45-degree field of view · retinal fundus photograph · 2048x1536px: 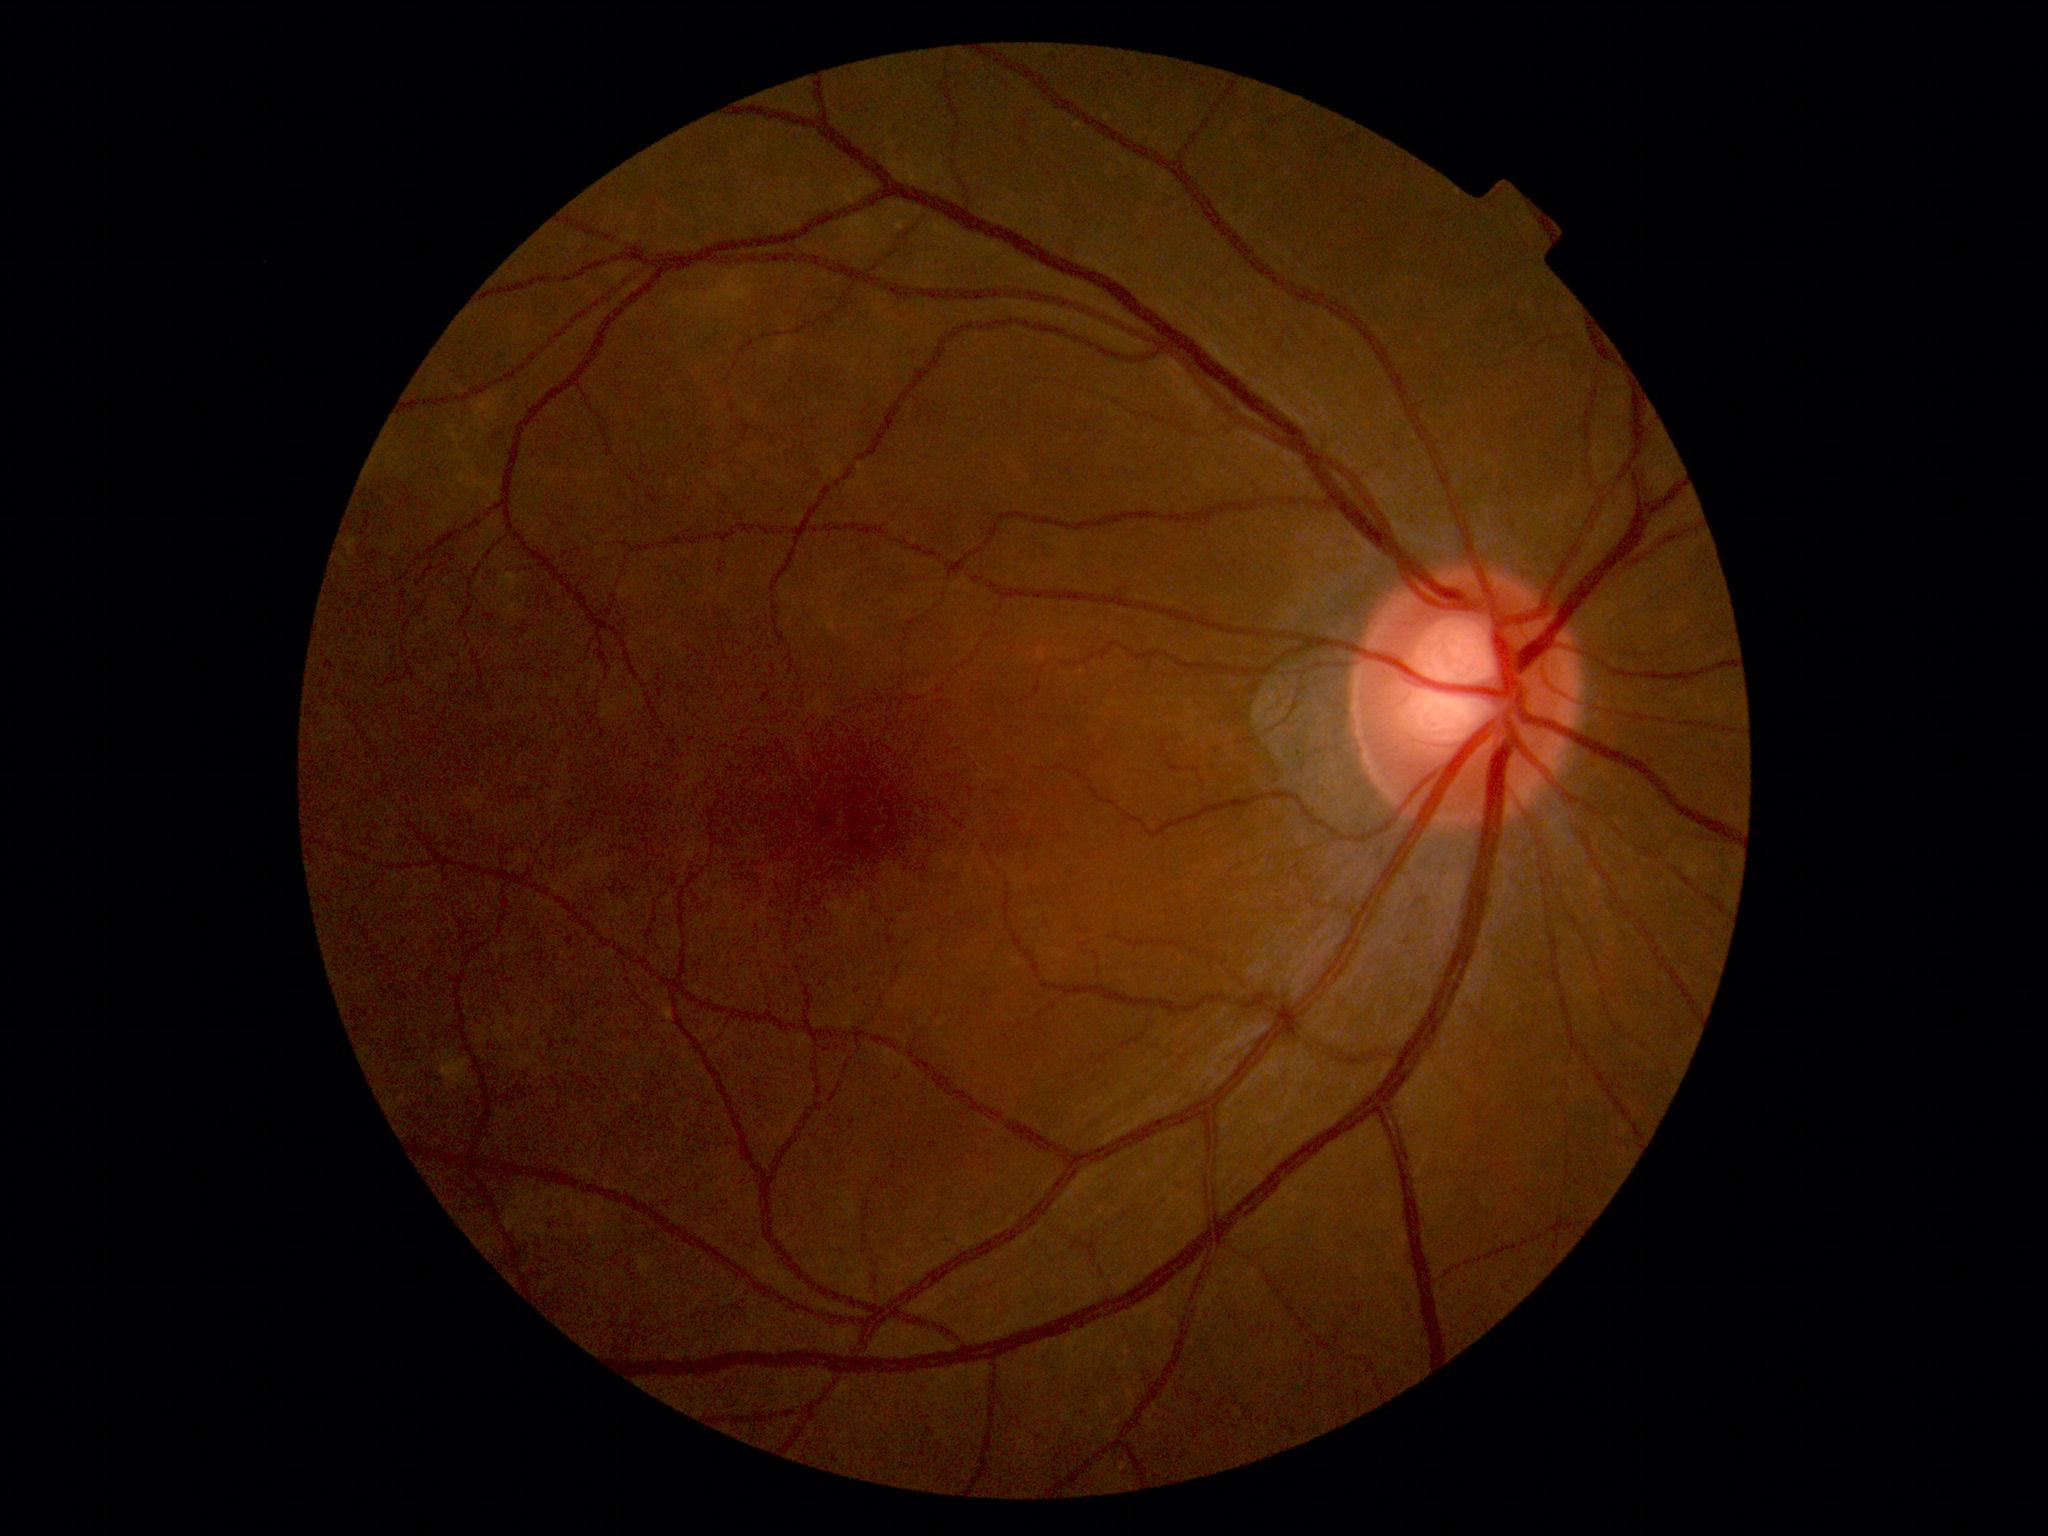 DR is 0/4 — no visible signs of diabetic retinopathy.